Color fundus image — 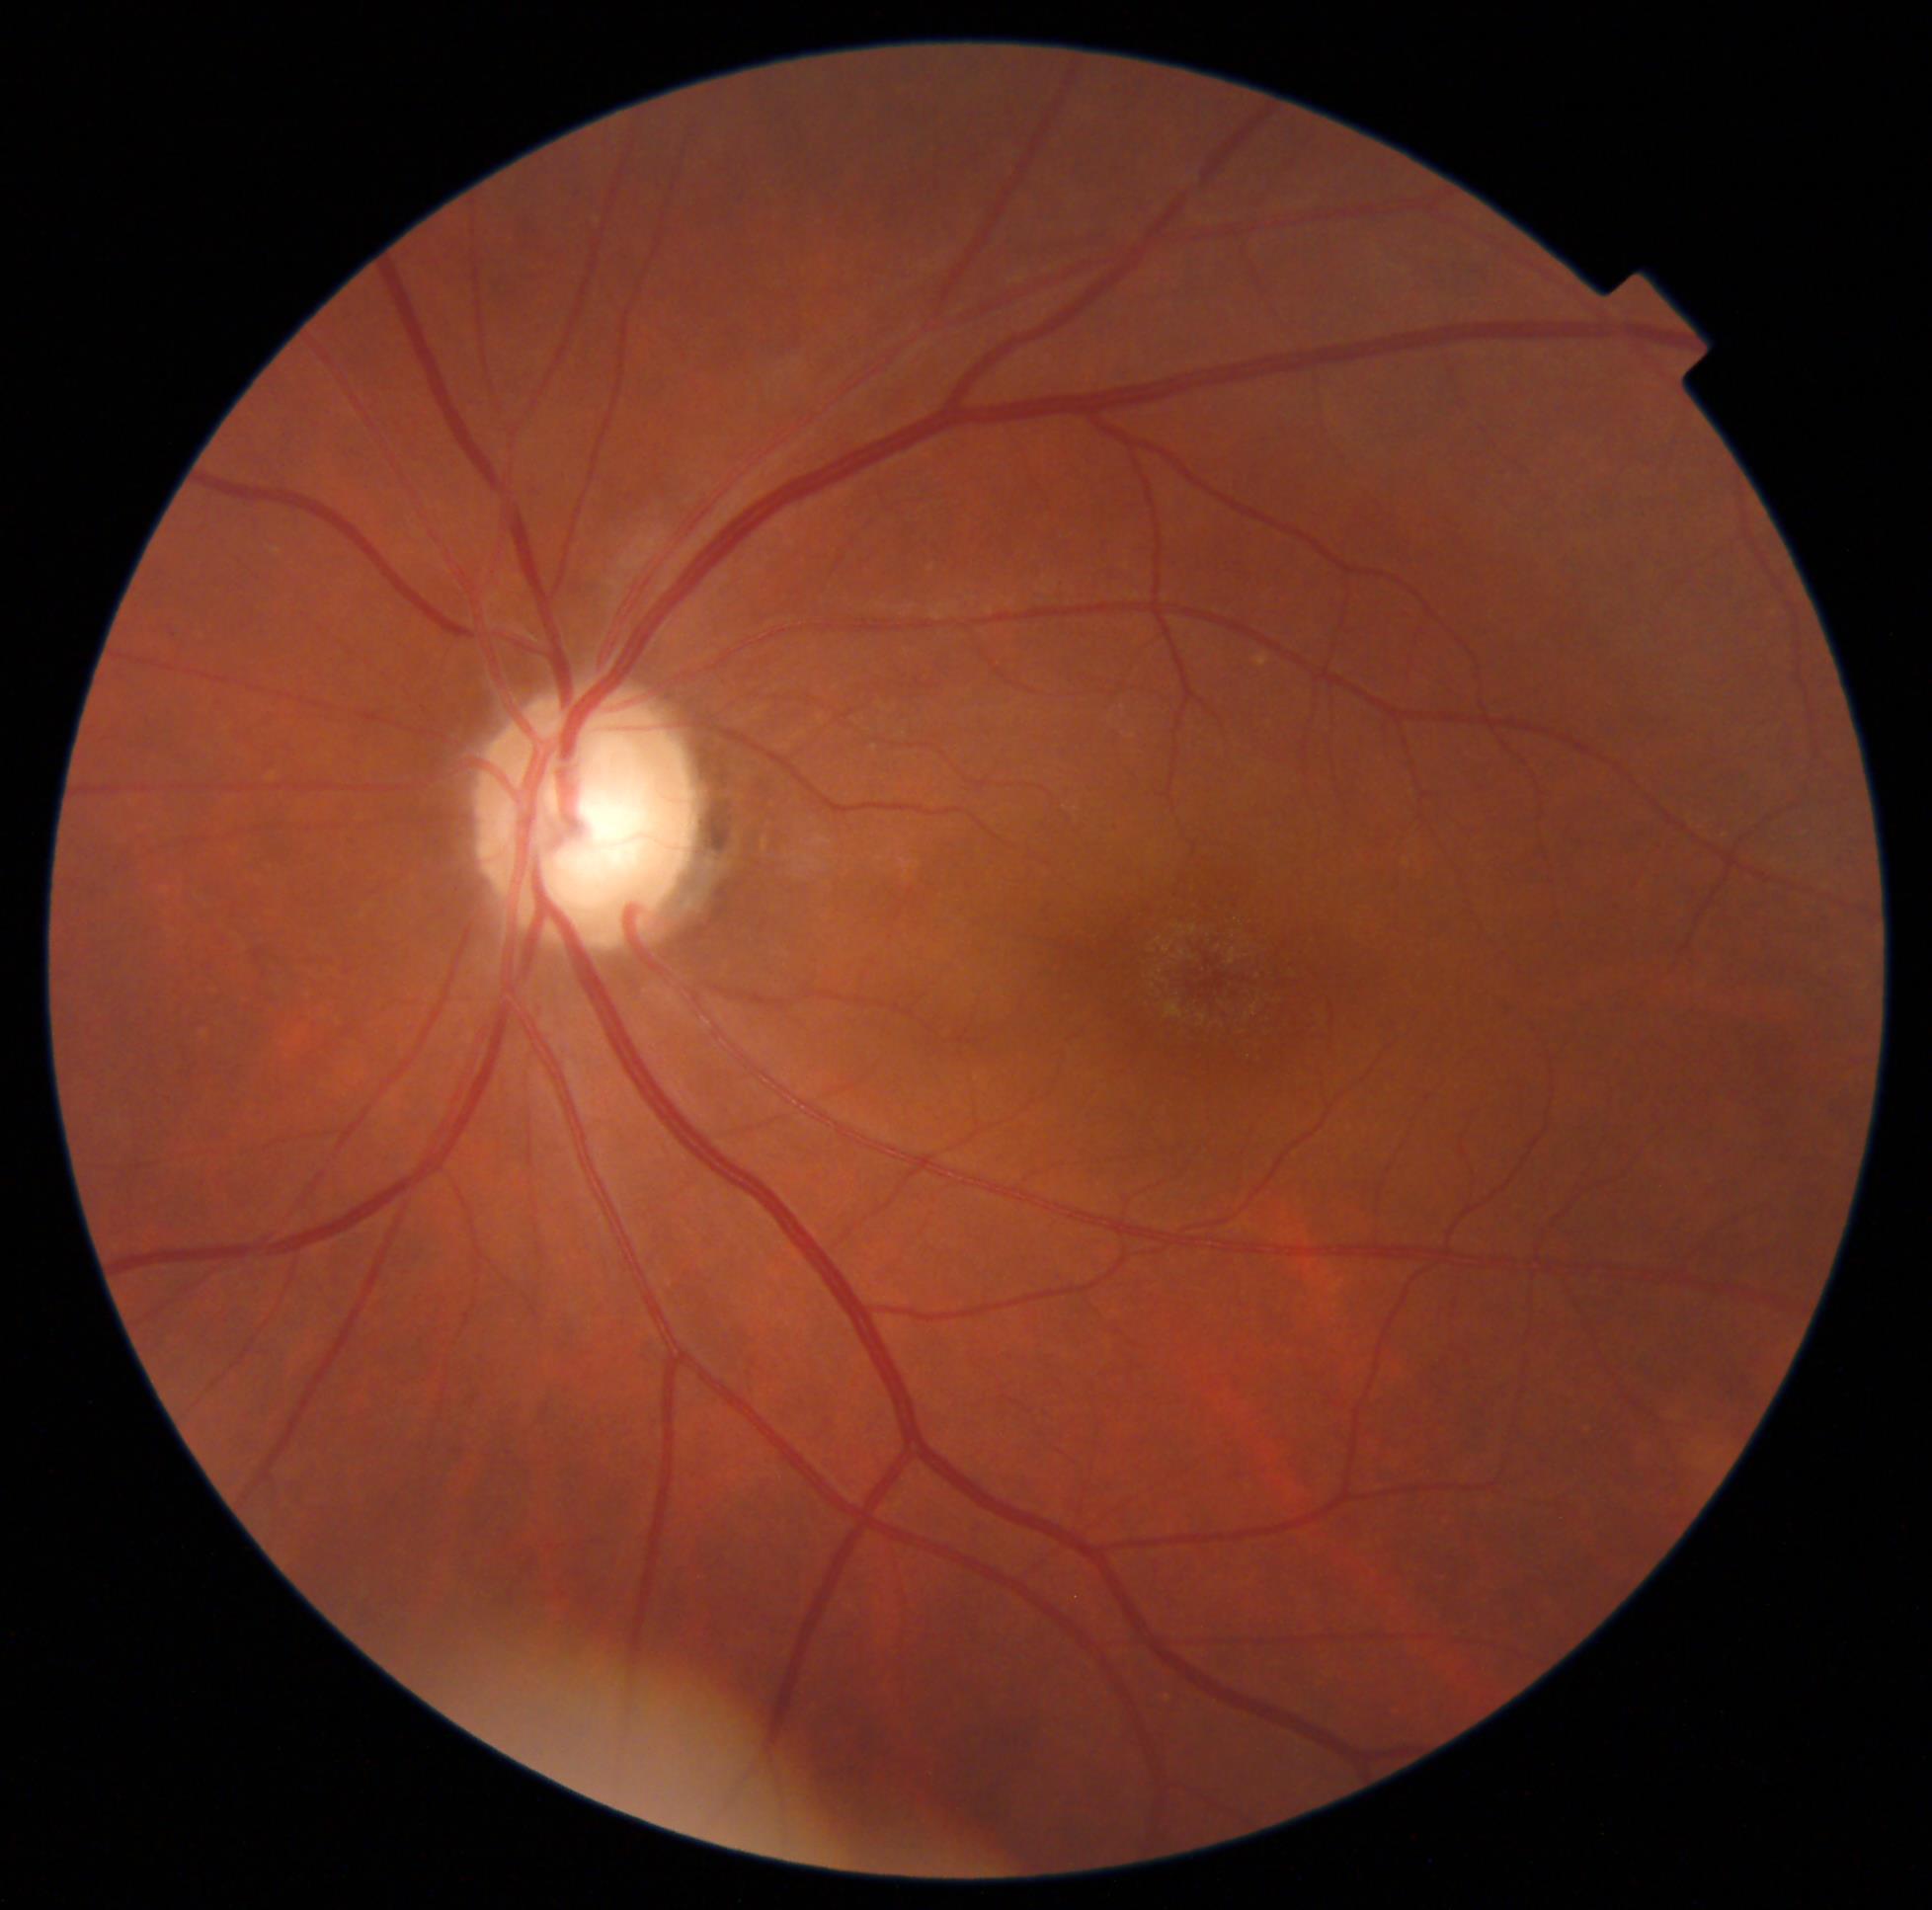
DR severity: grade 0 (no apparent retinopathy).